45-degree field of view, 1932x1916px — 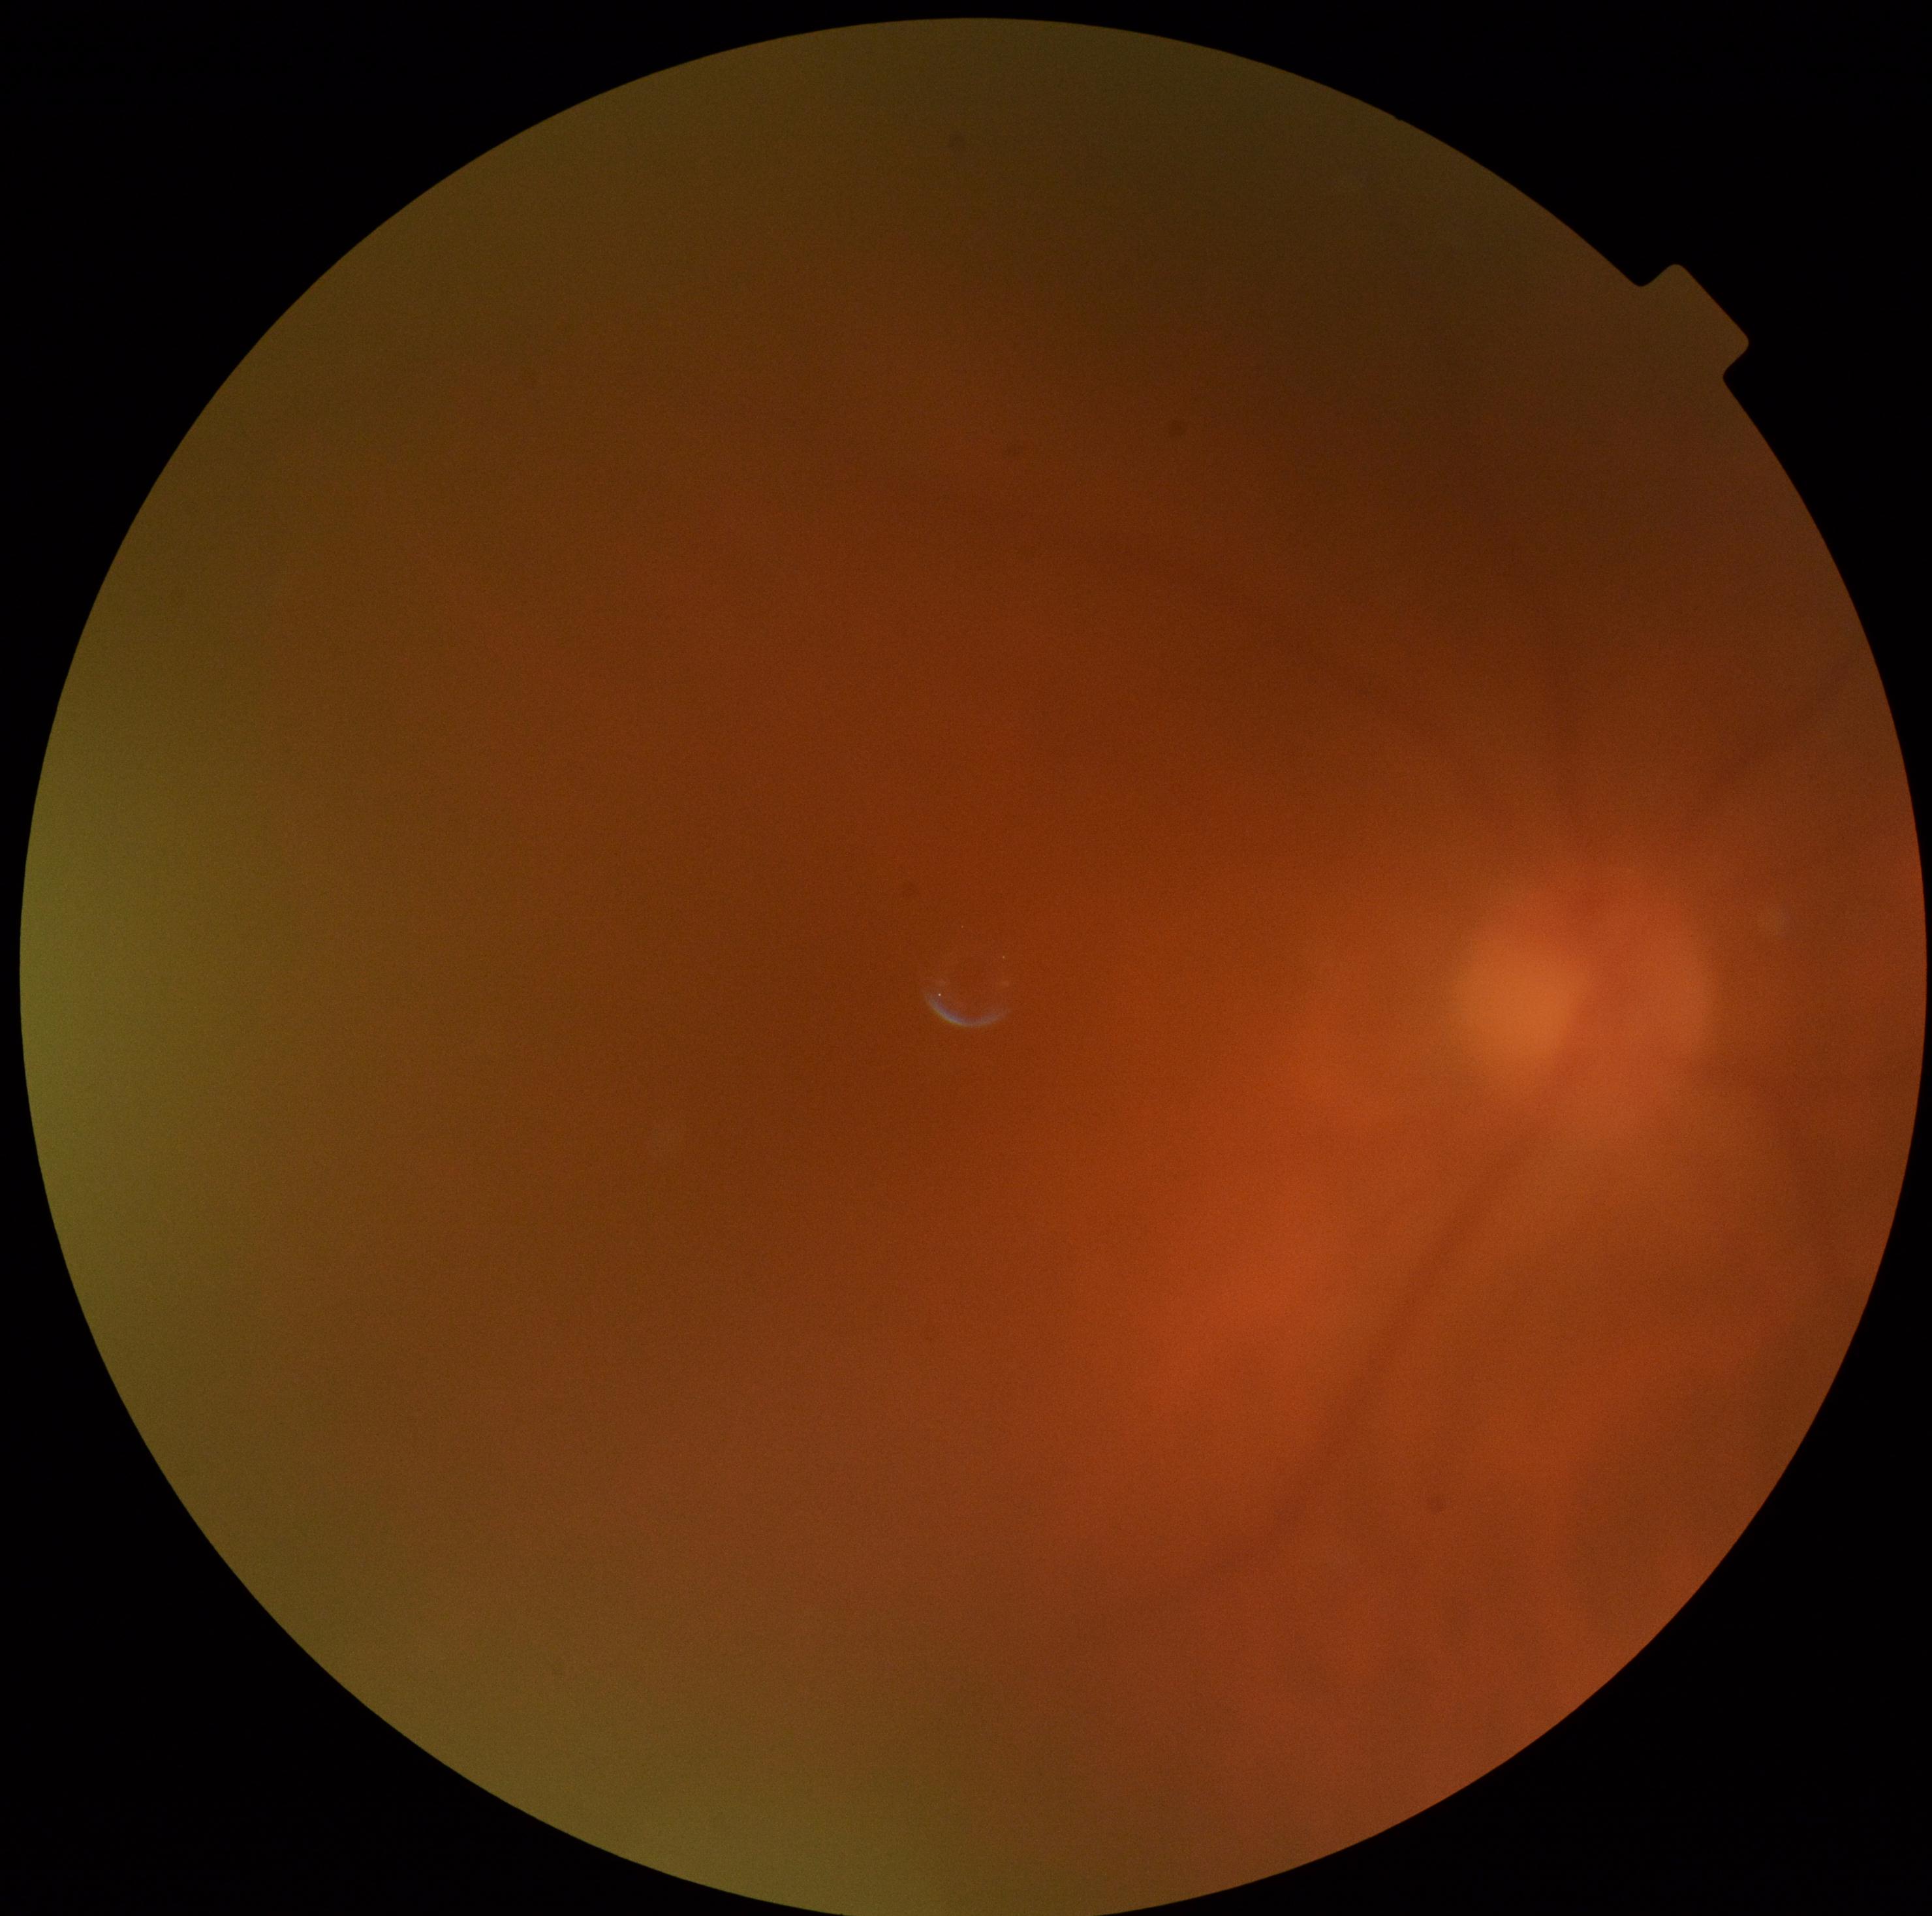 DR = ungradable due to poor image quality